848 x 848 pixels: 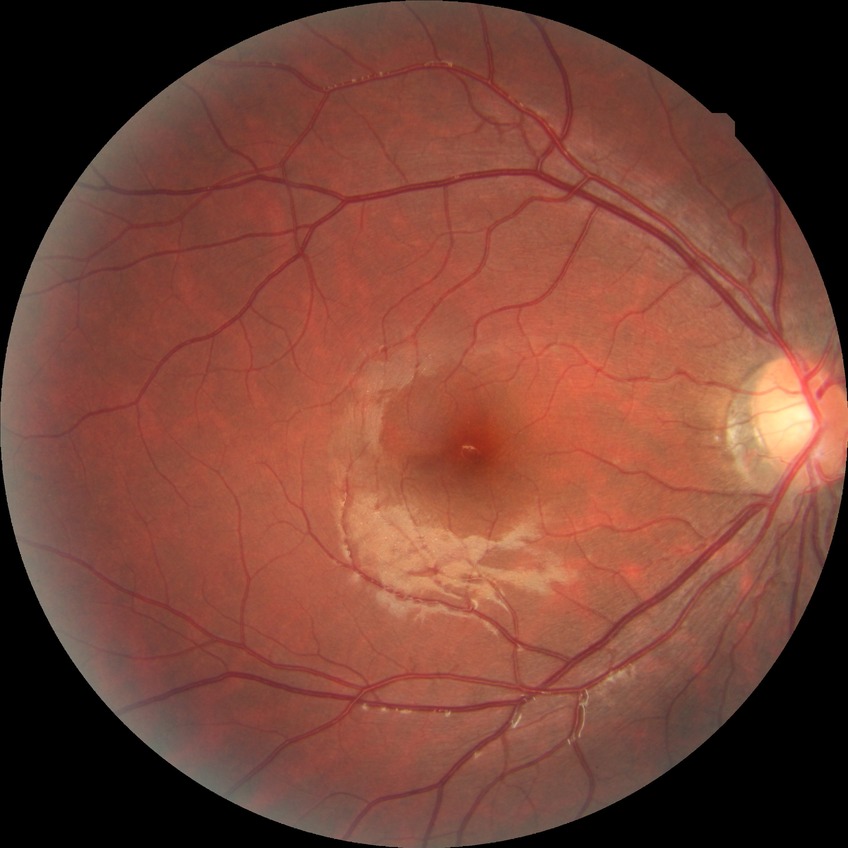

diabetic retinopathy (DR): no diabetic retinopathy (NDR)